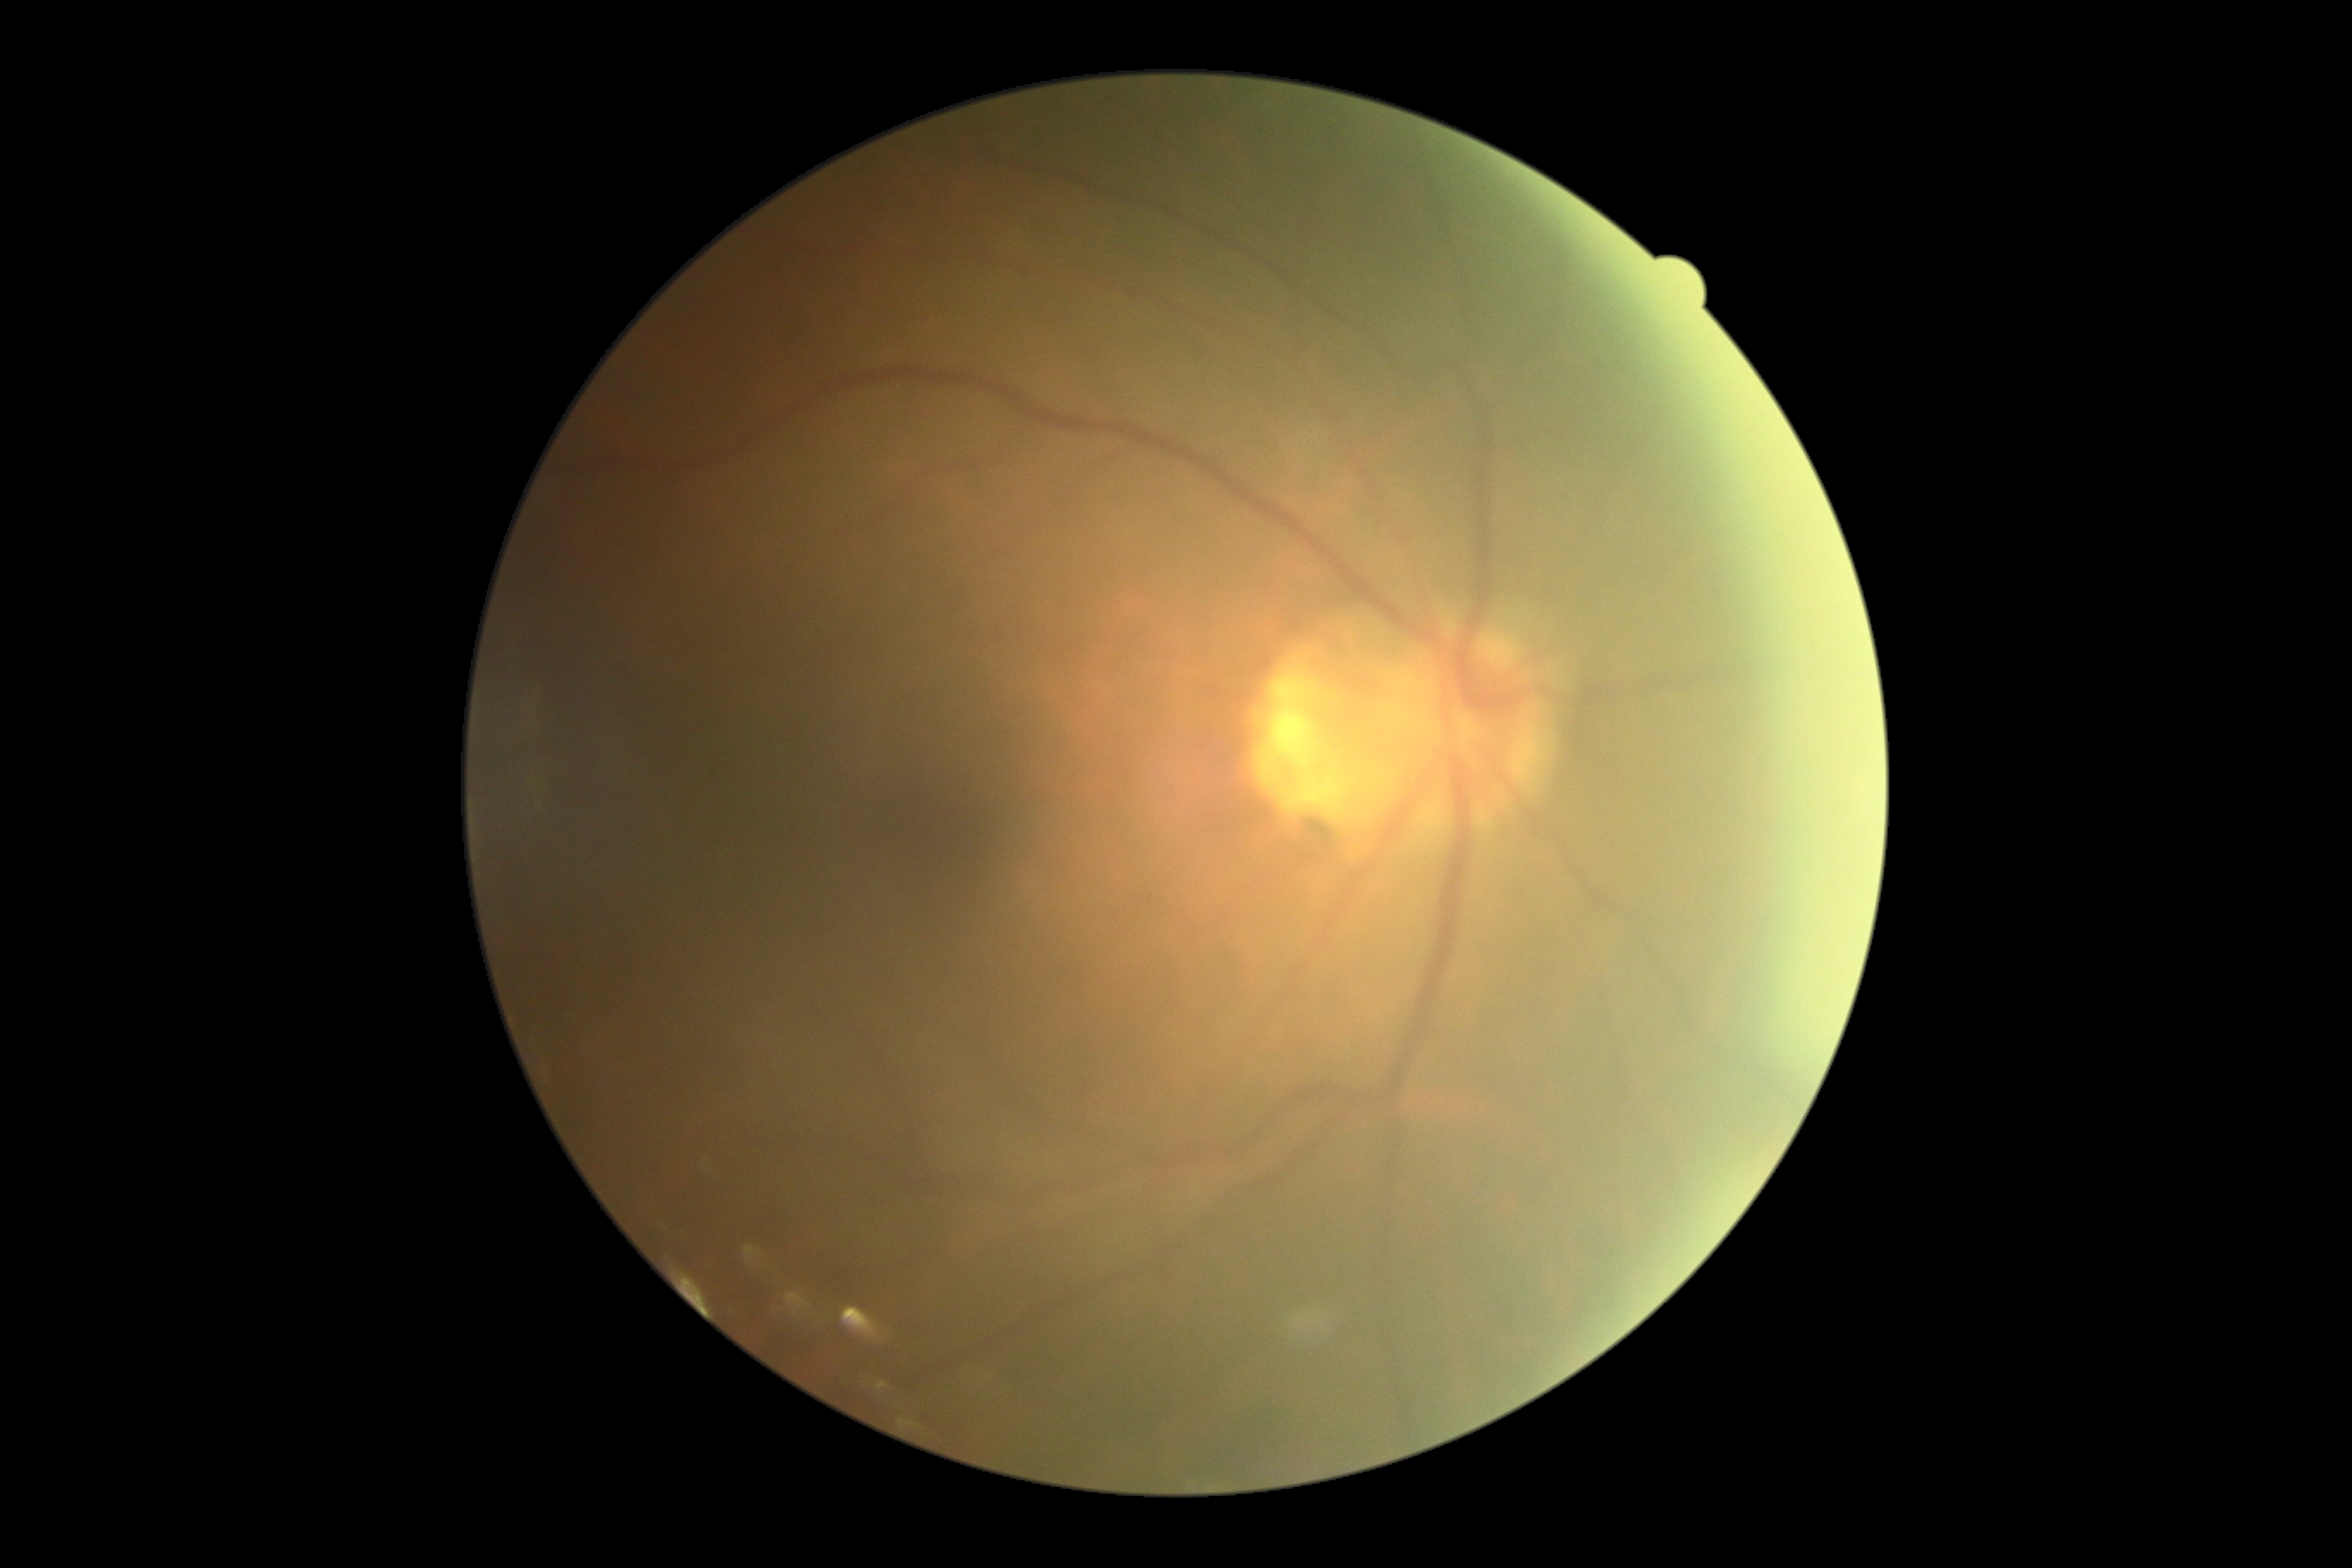 DR impression: no DR findings; DR: grade 0 (no apparent retinopathy) — no visible signs of diabetic retinopathy.